Modified Davis grading:
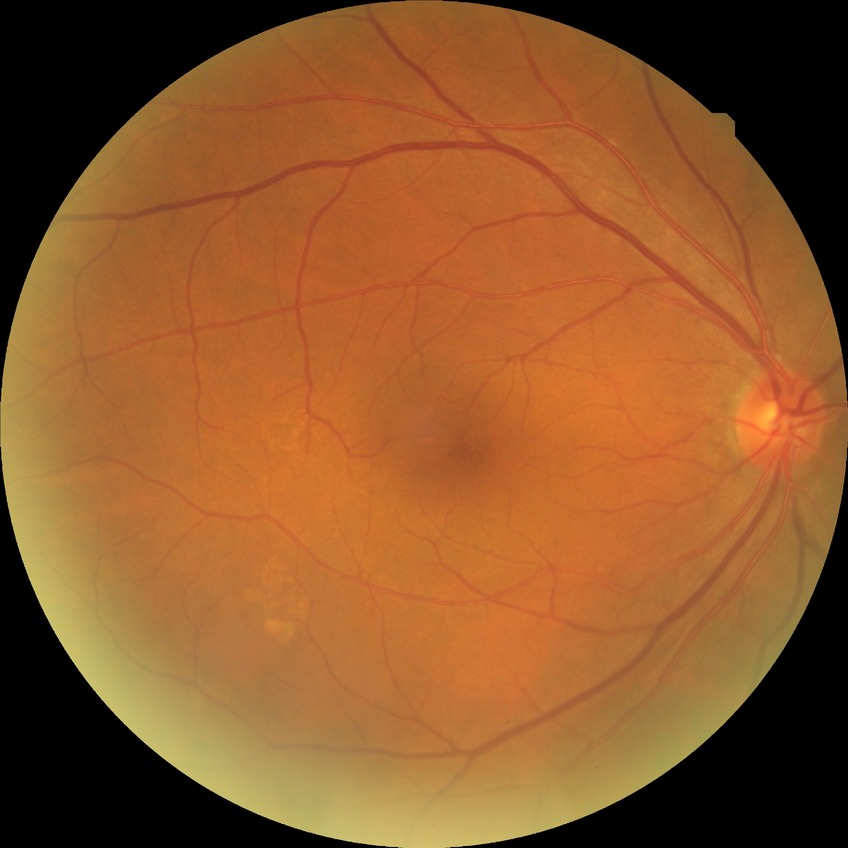
retinopathy stage = no diabetic retinopathy.